Pediatric wide-field fundus photograph.
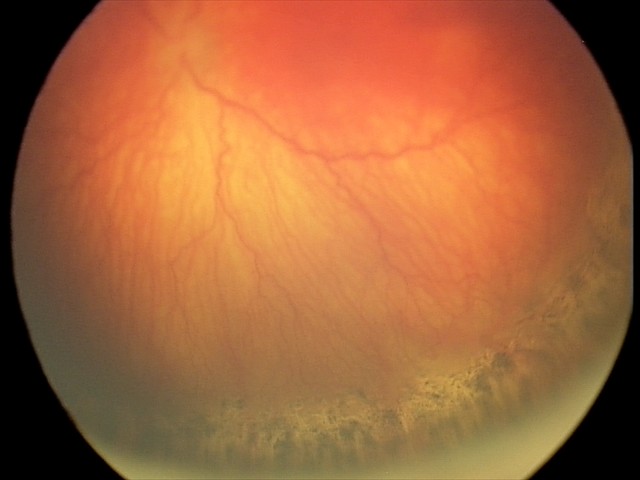

Screening series with A-ROP (aggressive ROP).